45° FOV; 2352x1568; CFP: 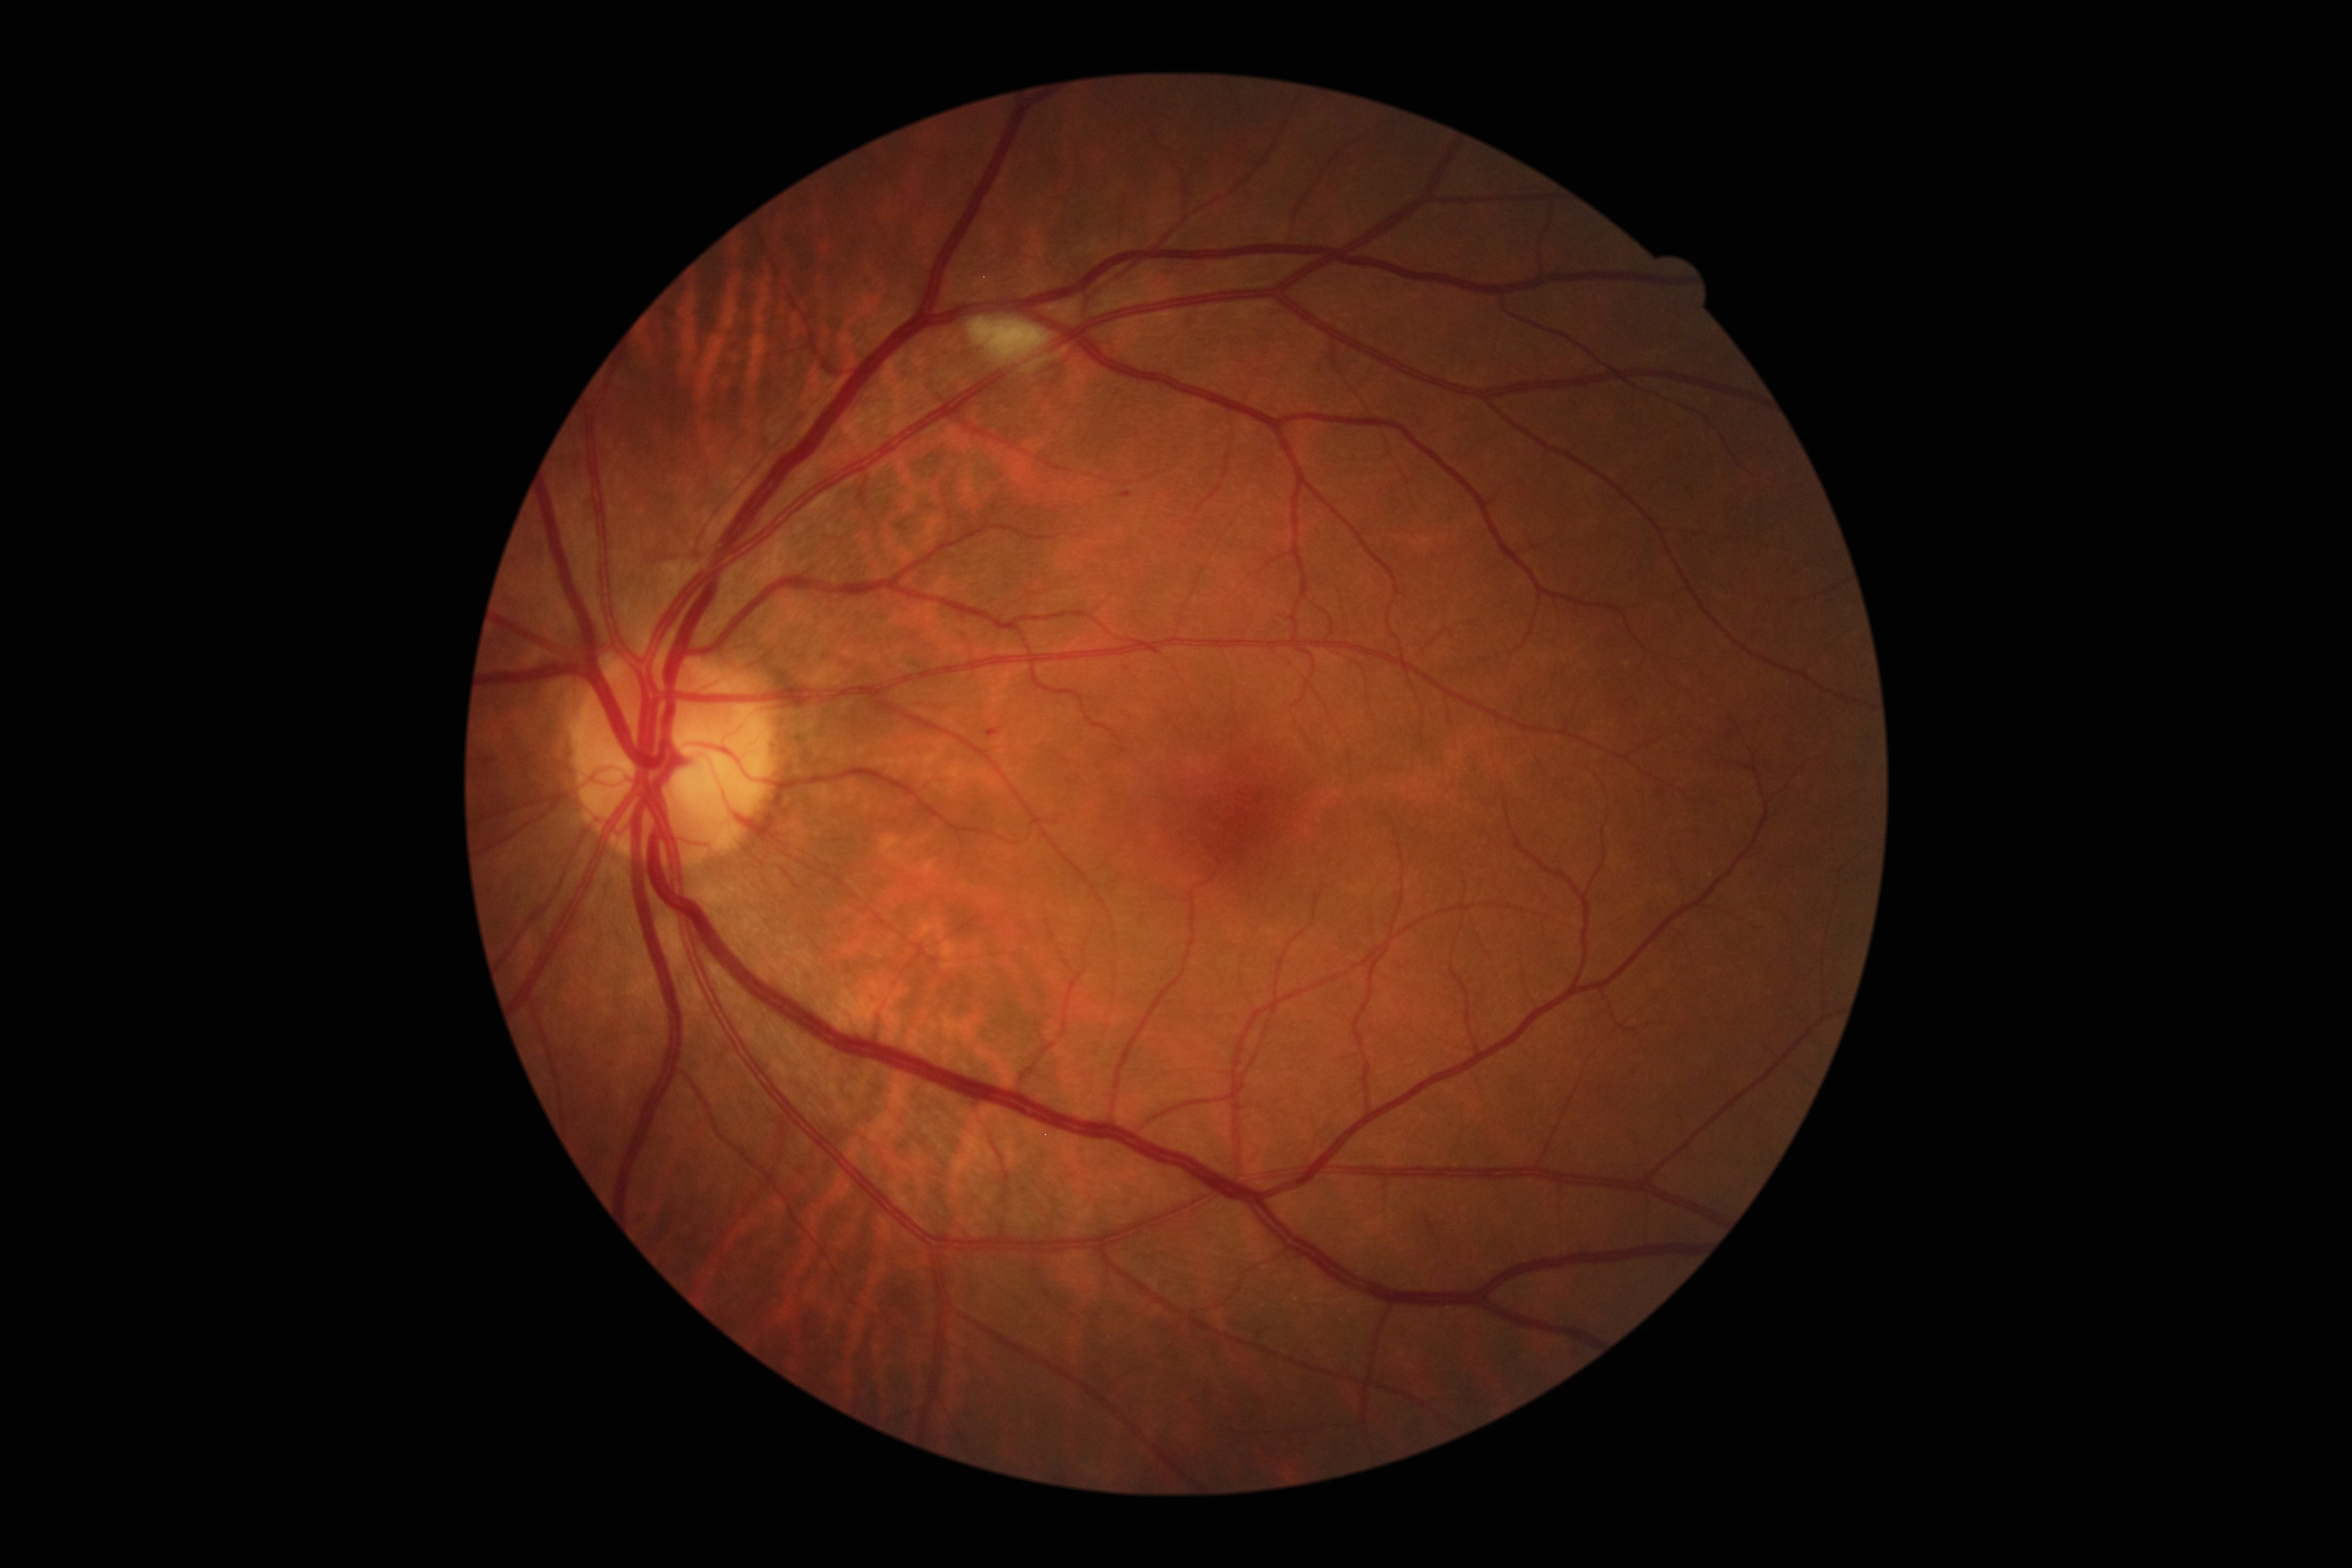 DR class: non-proliferative diabetic retinopathy
DR grade: 2